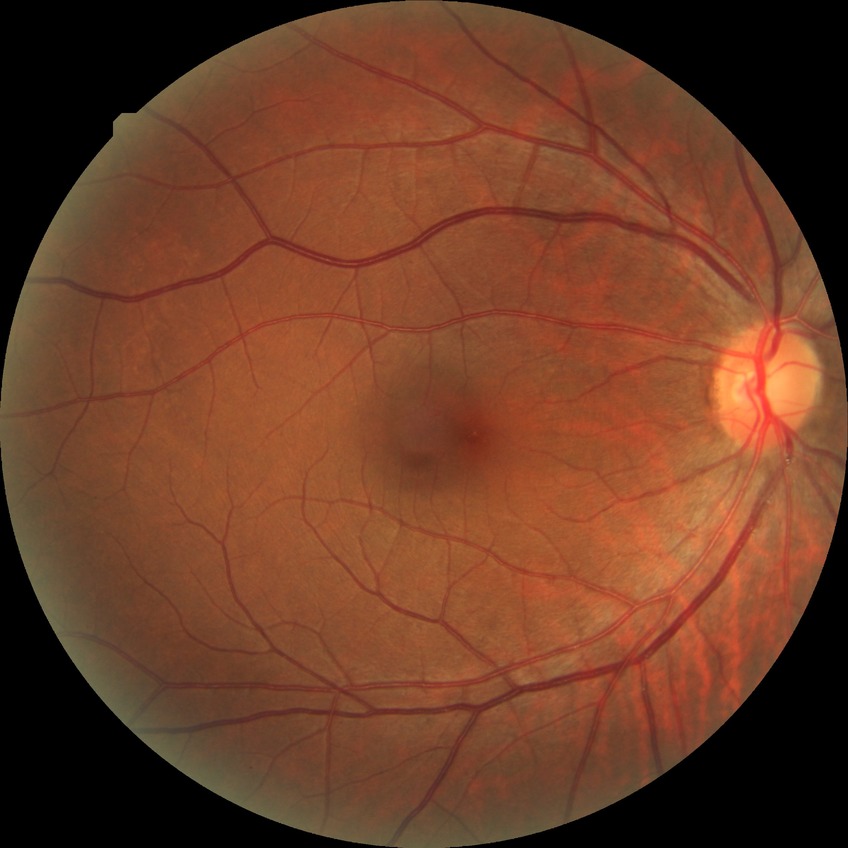

Diabetic retinopathy (DR) is NDR (no diabetic retinopathy).